2352x1568px; 45-degree field of view: 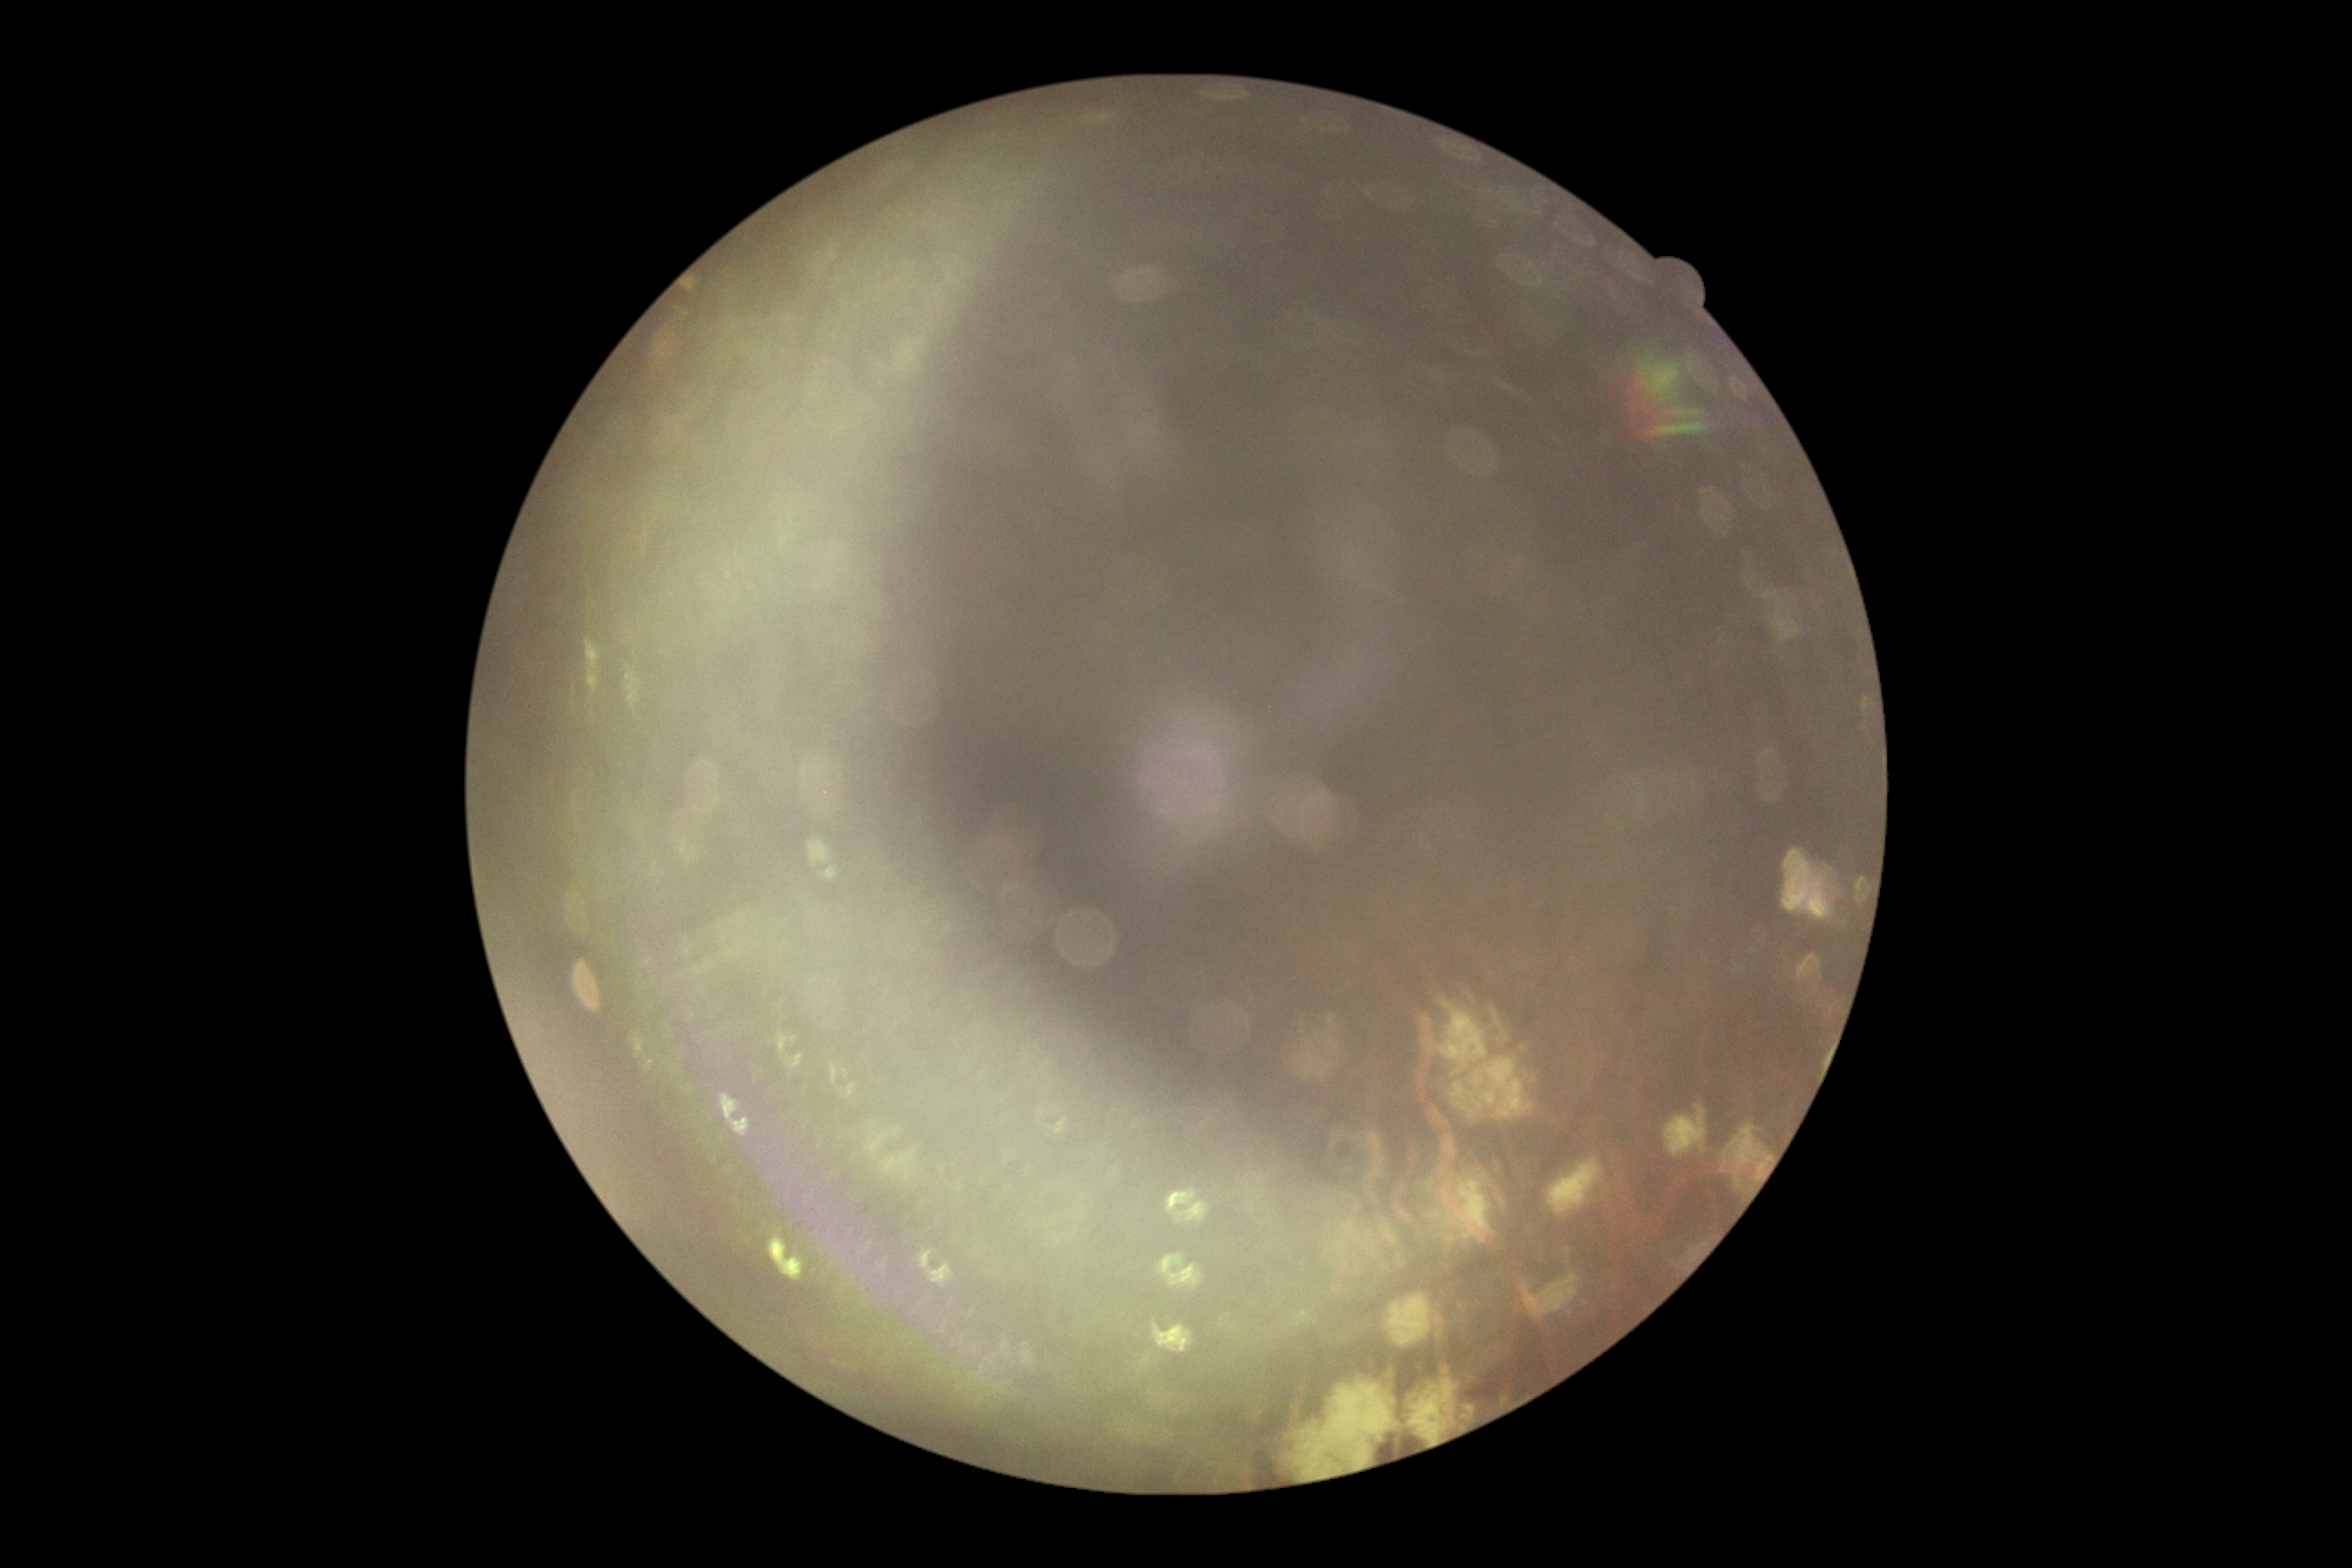 Findings:
– image quality: insufficient for DR assessment
– DR grade: ungradable